Modified Davis classification · 848x848.
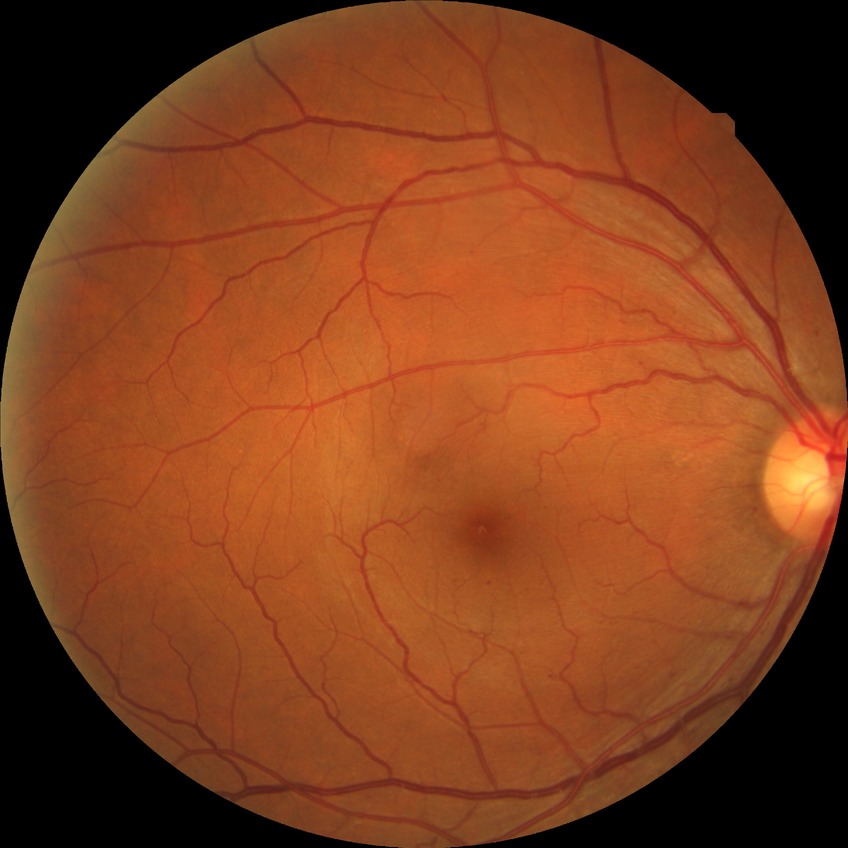 The retinopathy is classified as non-proliferative diabetic retinopathy.
Retinopathy stage: simple diabetic retinopathy.